Infant wide-field retinal image:
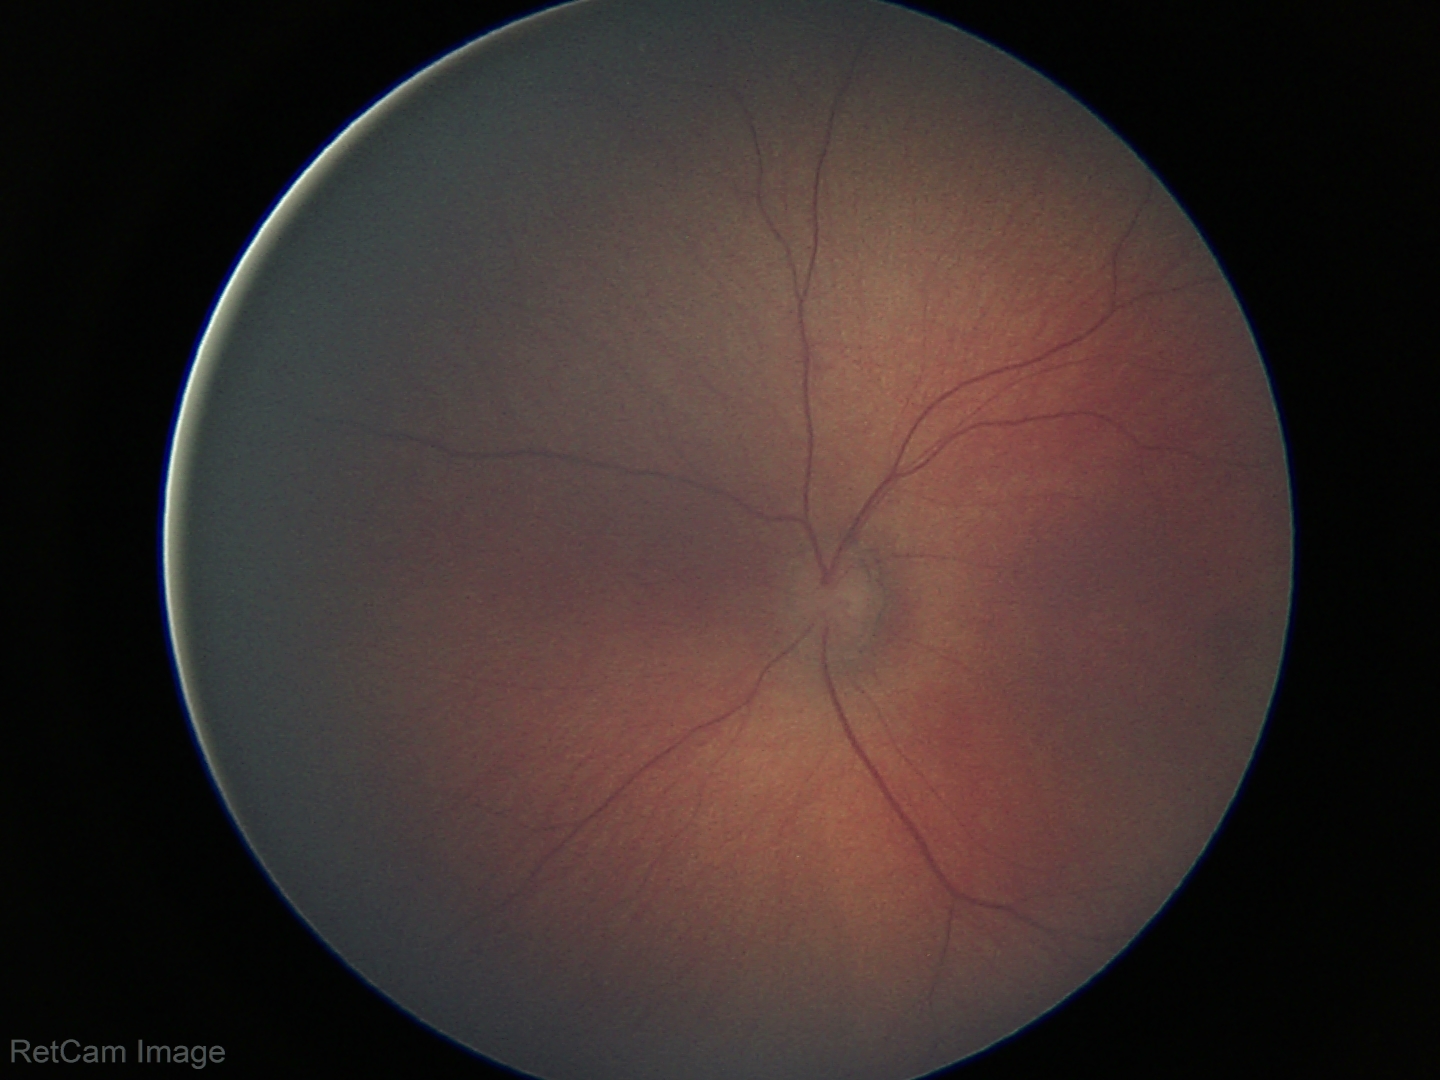
Screening: physiological appearance with no retinal pathology.